848 x 848 pixels; acquired with a NIDEK AFC-230: 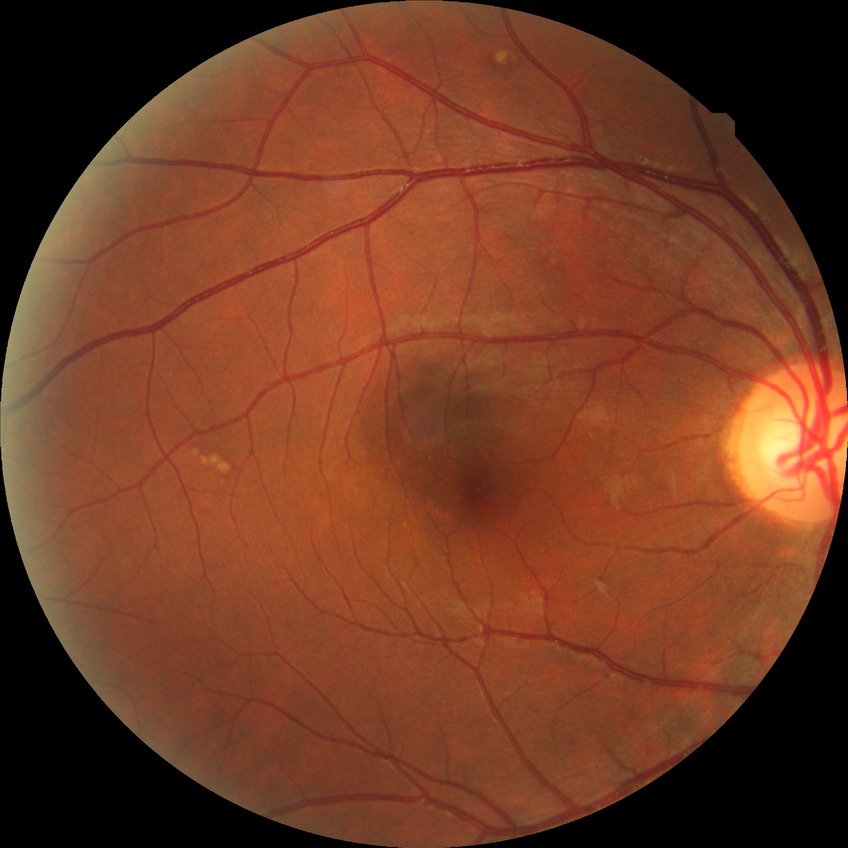 • diabetic retinopathy severity: no diabetic retinopathy